FOV: 45 degrees, 2352 x 1568 pixels, color fundus image:
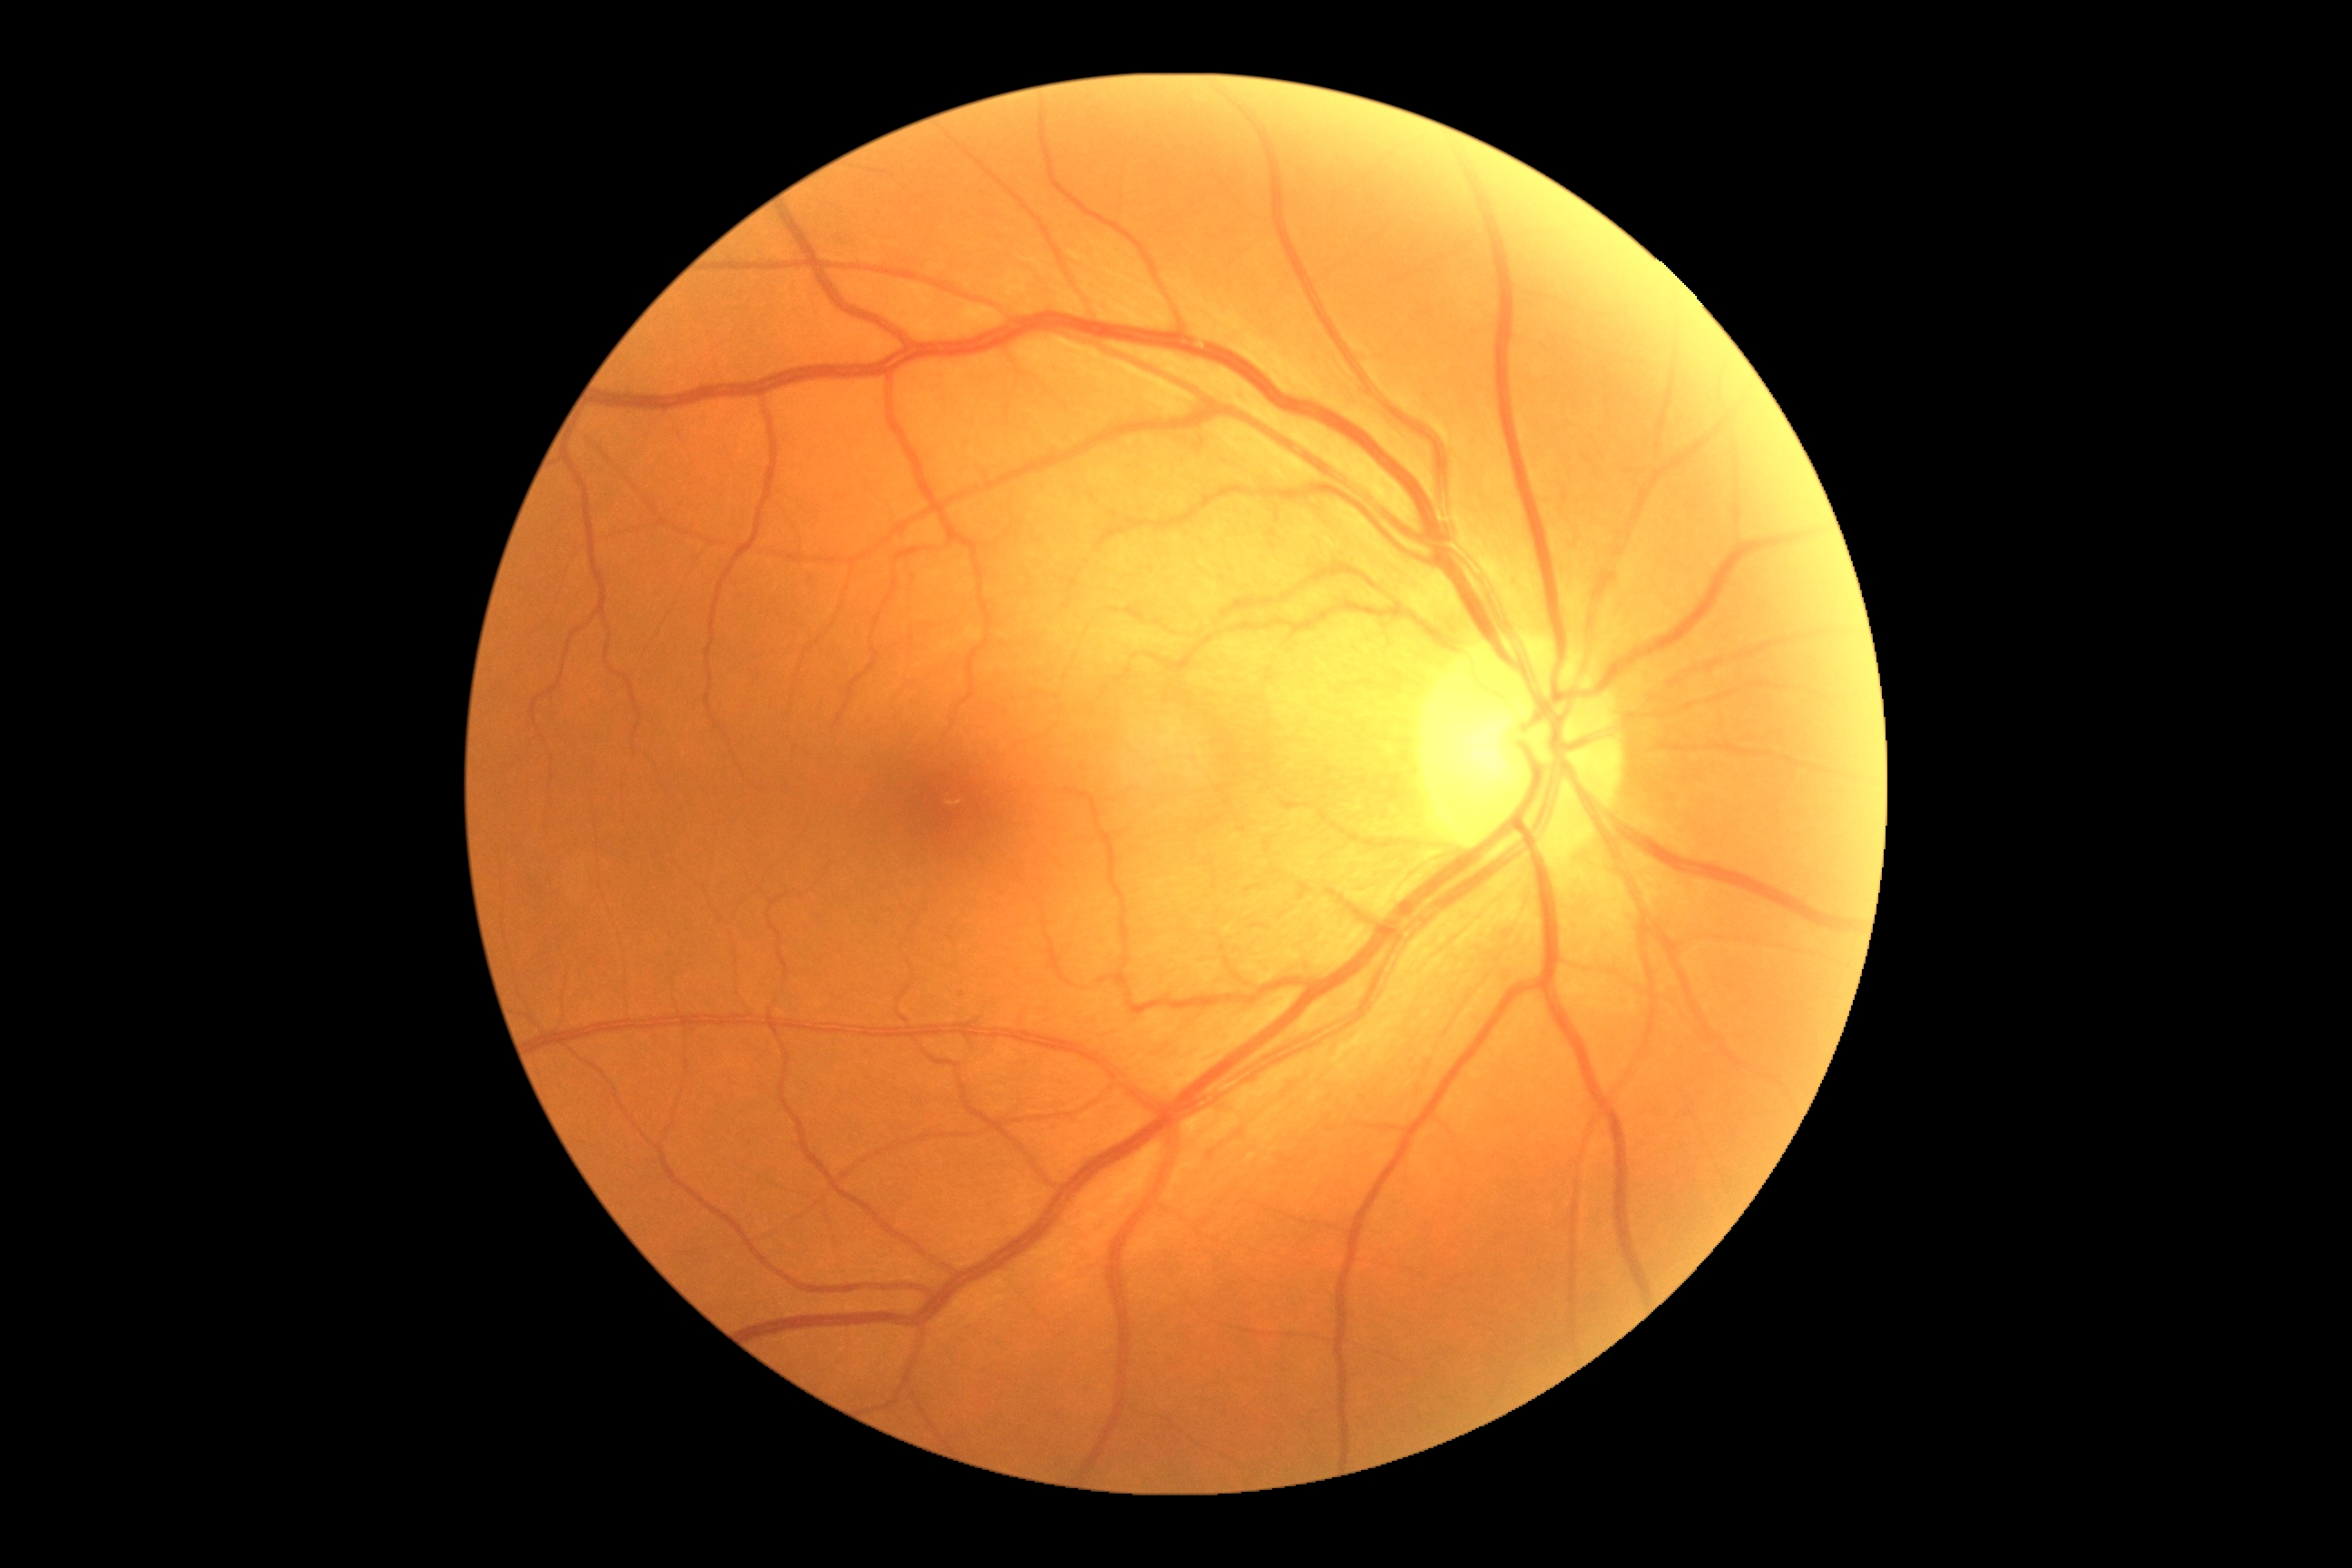

No apparent diabetic retinopathy.
Diabetic retinopathy grade is no apparent diabetic retinopathy (0) — no visible signs of diabetic retinopathy.